2352x1568px.
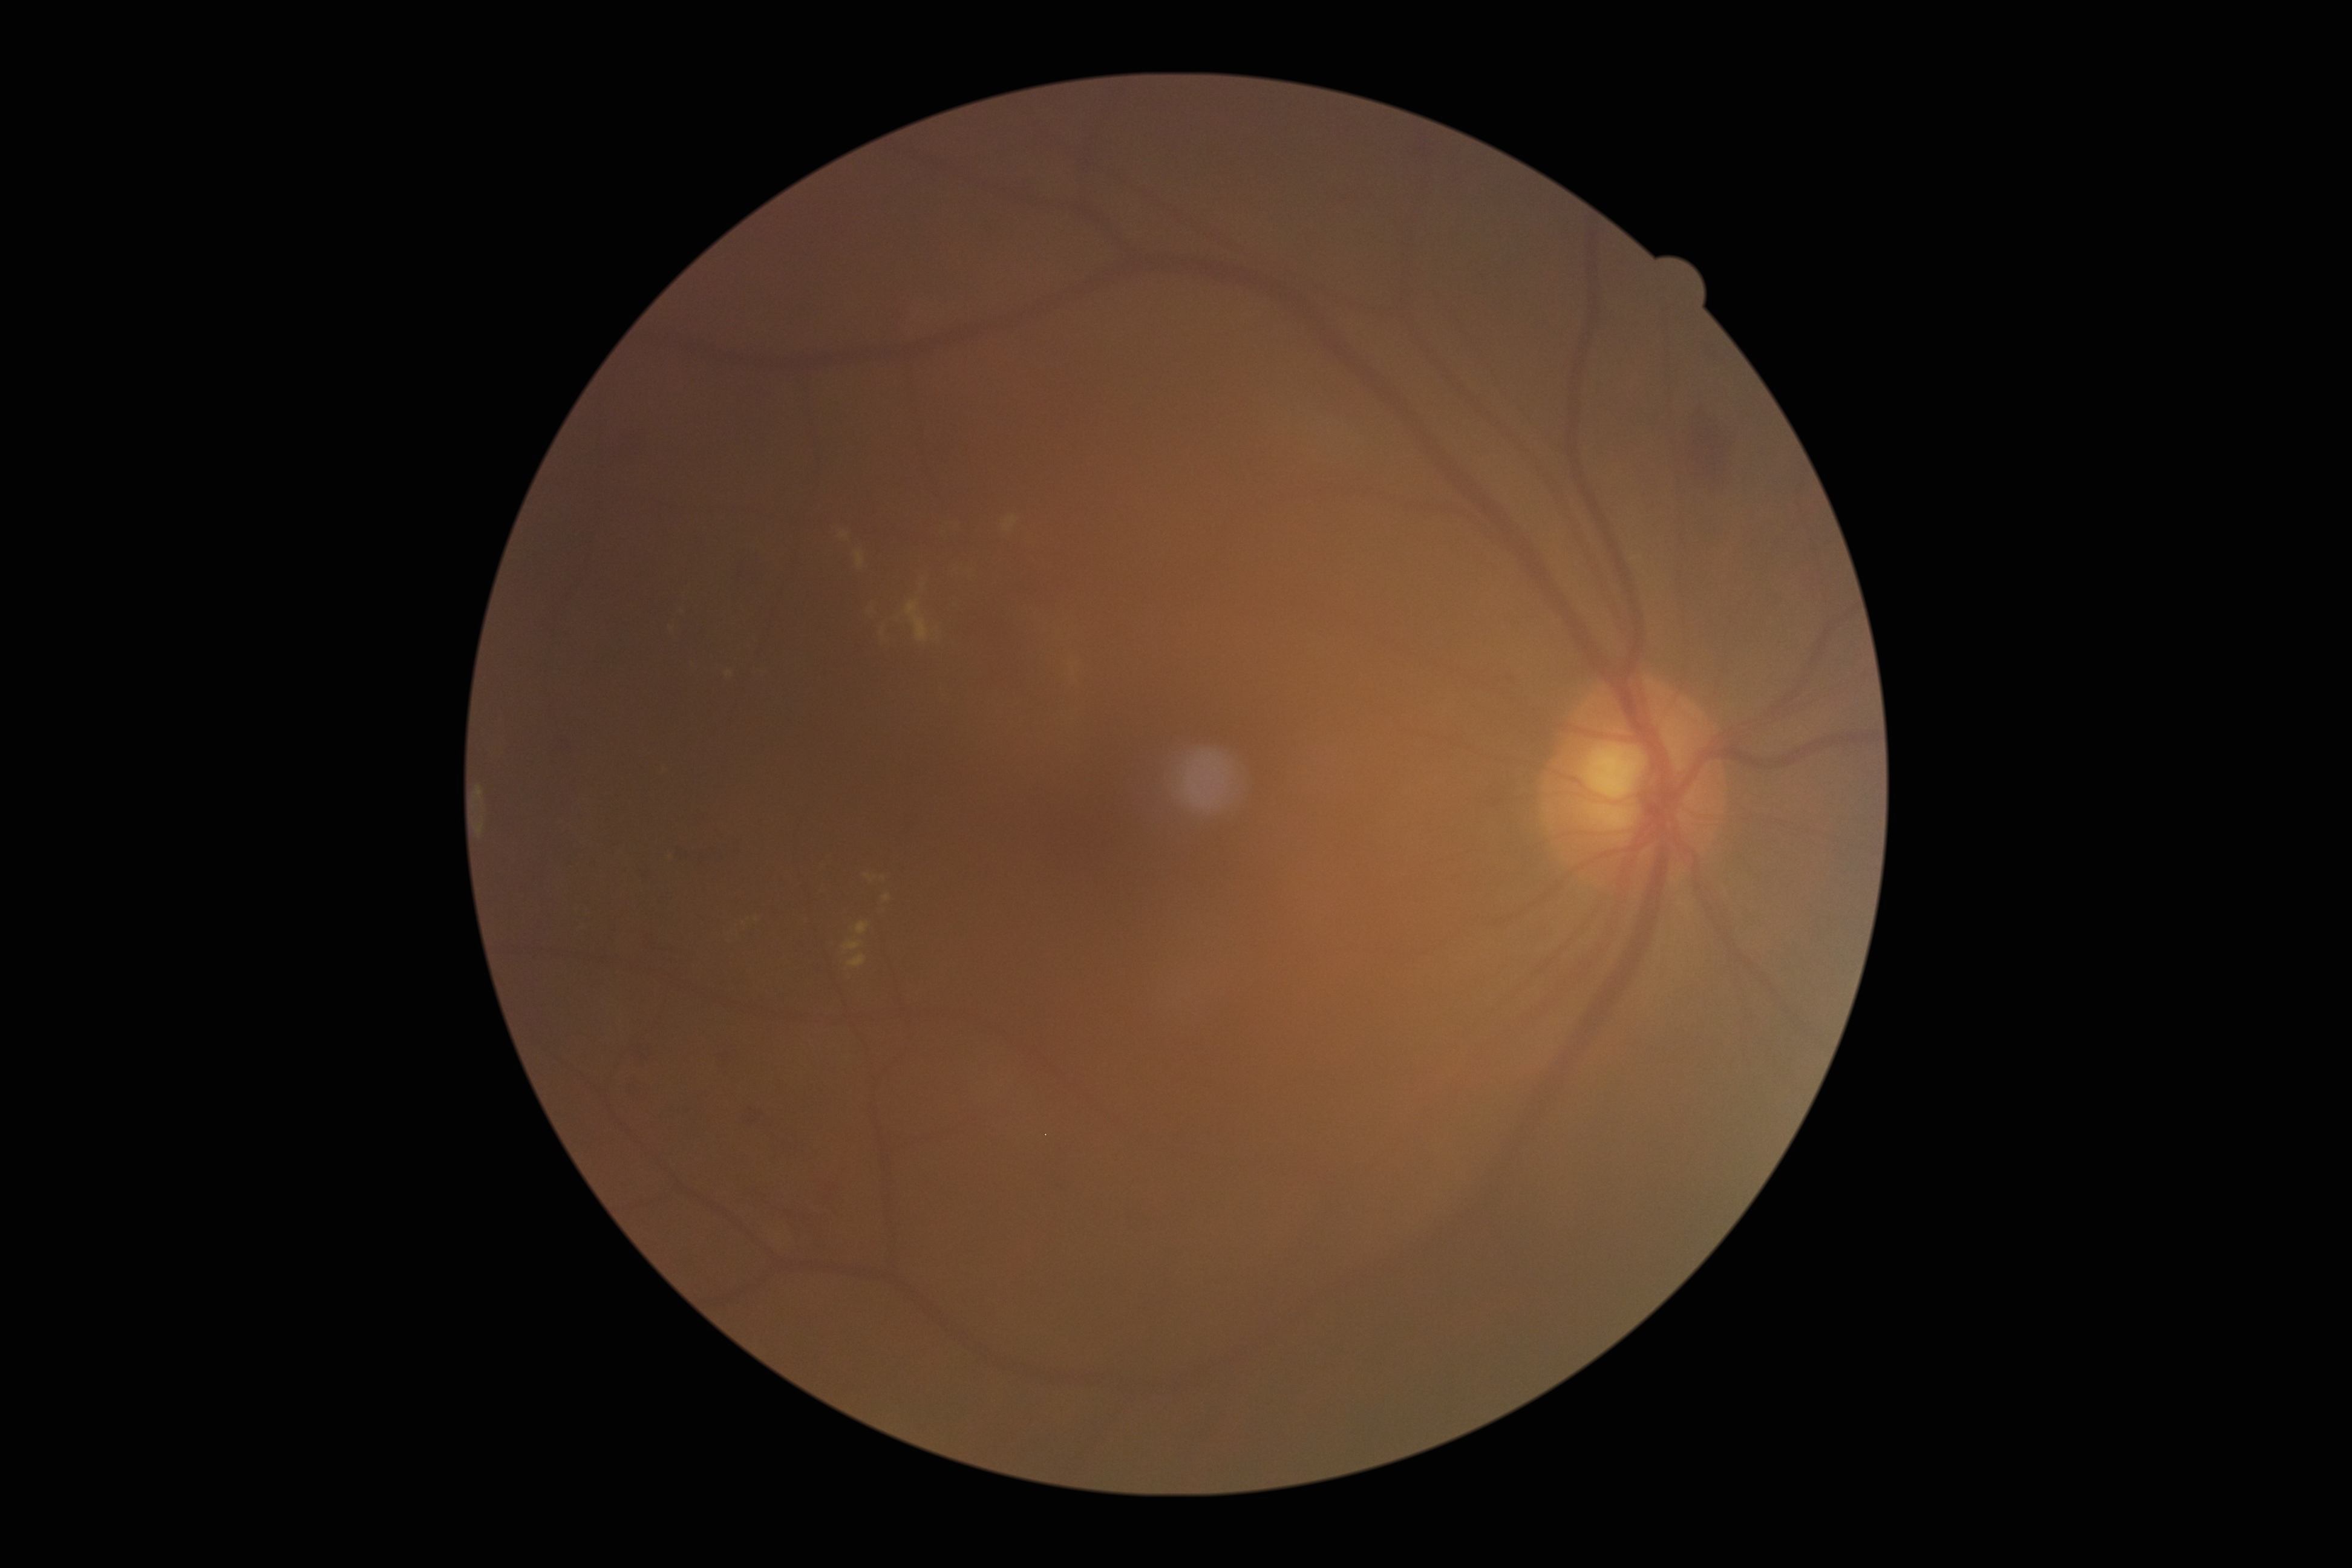

Diabetic retinopathy (DR) is moderate NPDR (grade 2).
No microaneurysms (MAs) identified.
Hard exudates (EXs) include those at (x1=826, y1=508, x2=1070, y2=702) | (x1=684, y1=662, x2=770, y2=681) | (x1=802, y1=914, x2=811, y2=925) | (x1=666, y1=579, x2=697, y2=643) | (x1=661, y1=848, x2=677, y2=861) | (x1=722, y1=914, x2=762, y2=944) | (x1=1030, y1=601, x2=1086, y2=722) | (x1=835, y1=863, x2=900, y2=970).
Hemorrhages (HEs) are located at (x1=740, y1=1103, x2=766, y2=1128) | (x1=982, y1=216, x2=1007, y2=239) | (x1=722, y1=549, x2=774, y2=599) | (x1=599, y1=431, x2=650, y2=474) | (x1=1489, y1=665, x2=1521, y2=690) | (x1=675, y1=804, x2=747, y2=869) | (x1=747, y1=1169, x2=849, y2=1255) | (x1=622, y1=1079, x2=648, y2=1102) | (x1=707, y1=1046, x2=741, y2=1074) | (x1=639, y1=931, x2=682, y2=955) | (x1=1685, y1=405, x2=1737, y2=497) | (x1=633, y1=867, x2=654, y2=886) | (x1=630, y1=1040, x2=656, y2=1064).
No soft exudates (SEs) identified.